Modified Davis grading · nonmydriatic · FOV: 45 degrees · NIDEK AFC-230.
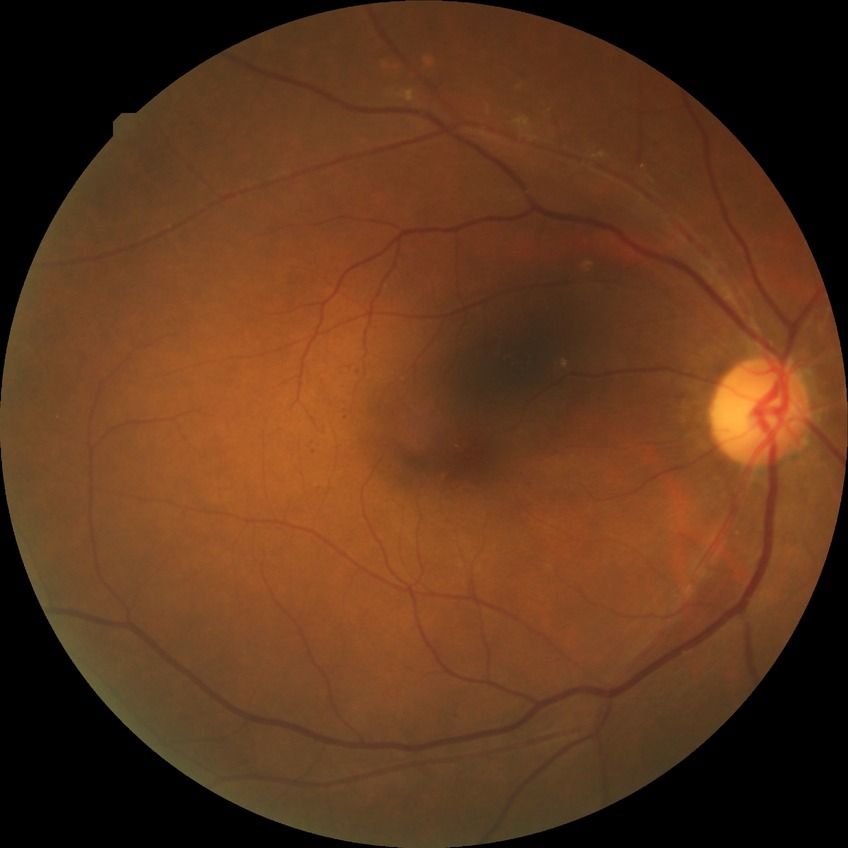 proliferative_class: non-proliferative diabetic retinopathy
davis_grade: simple diabetic retinopathy (SDR)